Retinal fundus photograph, 2212 by 1659 pixels — 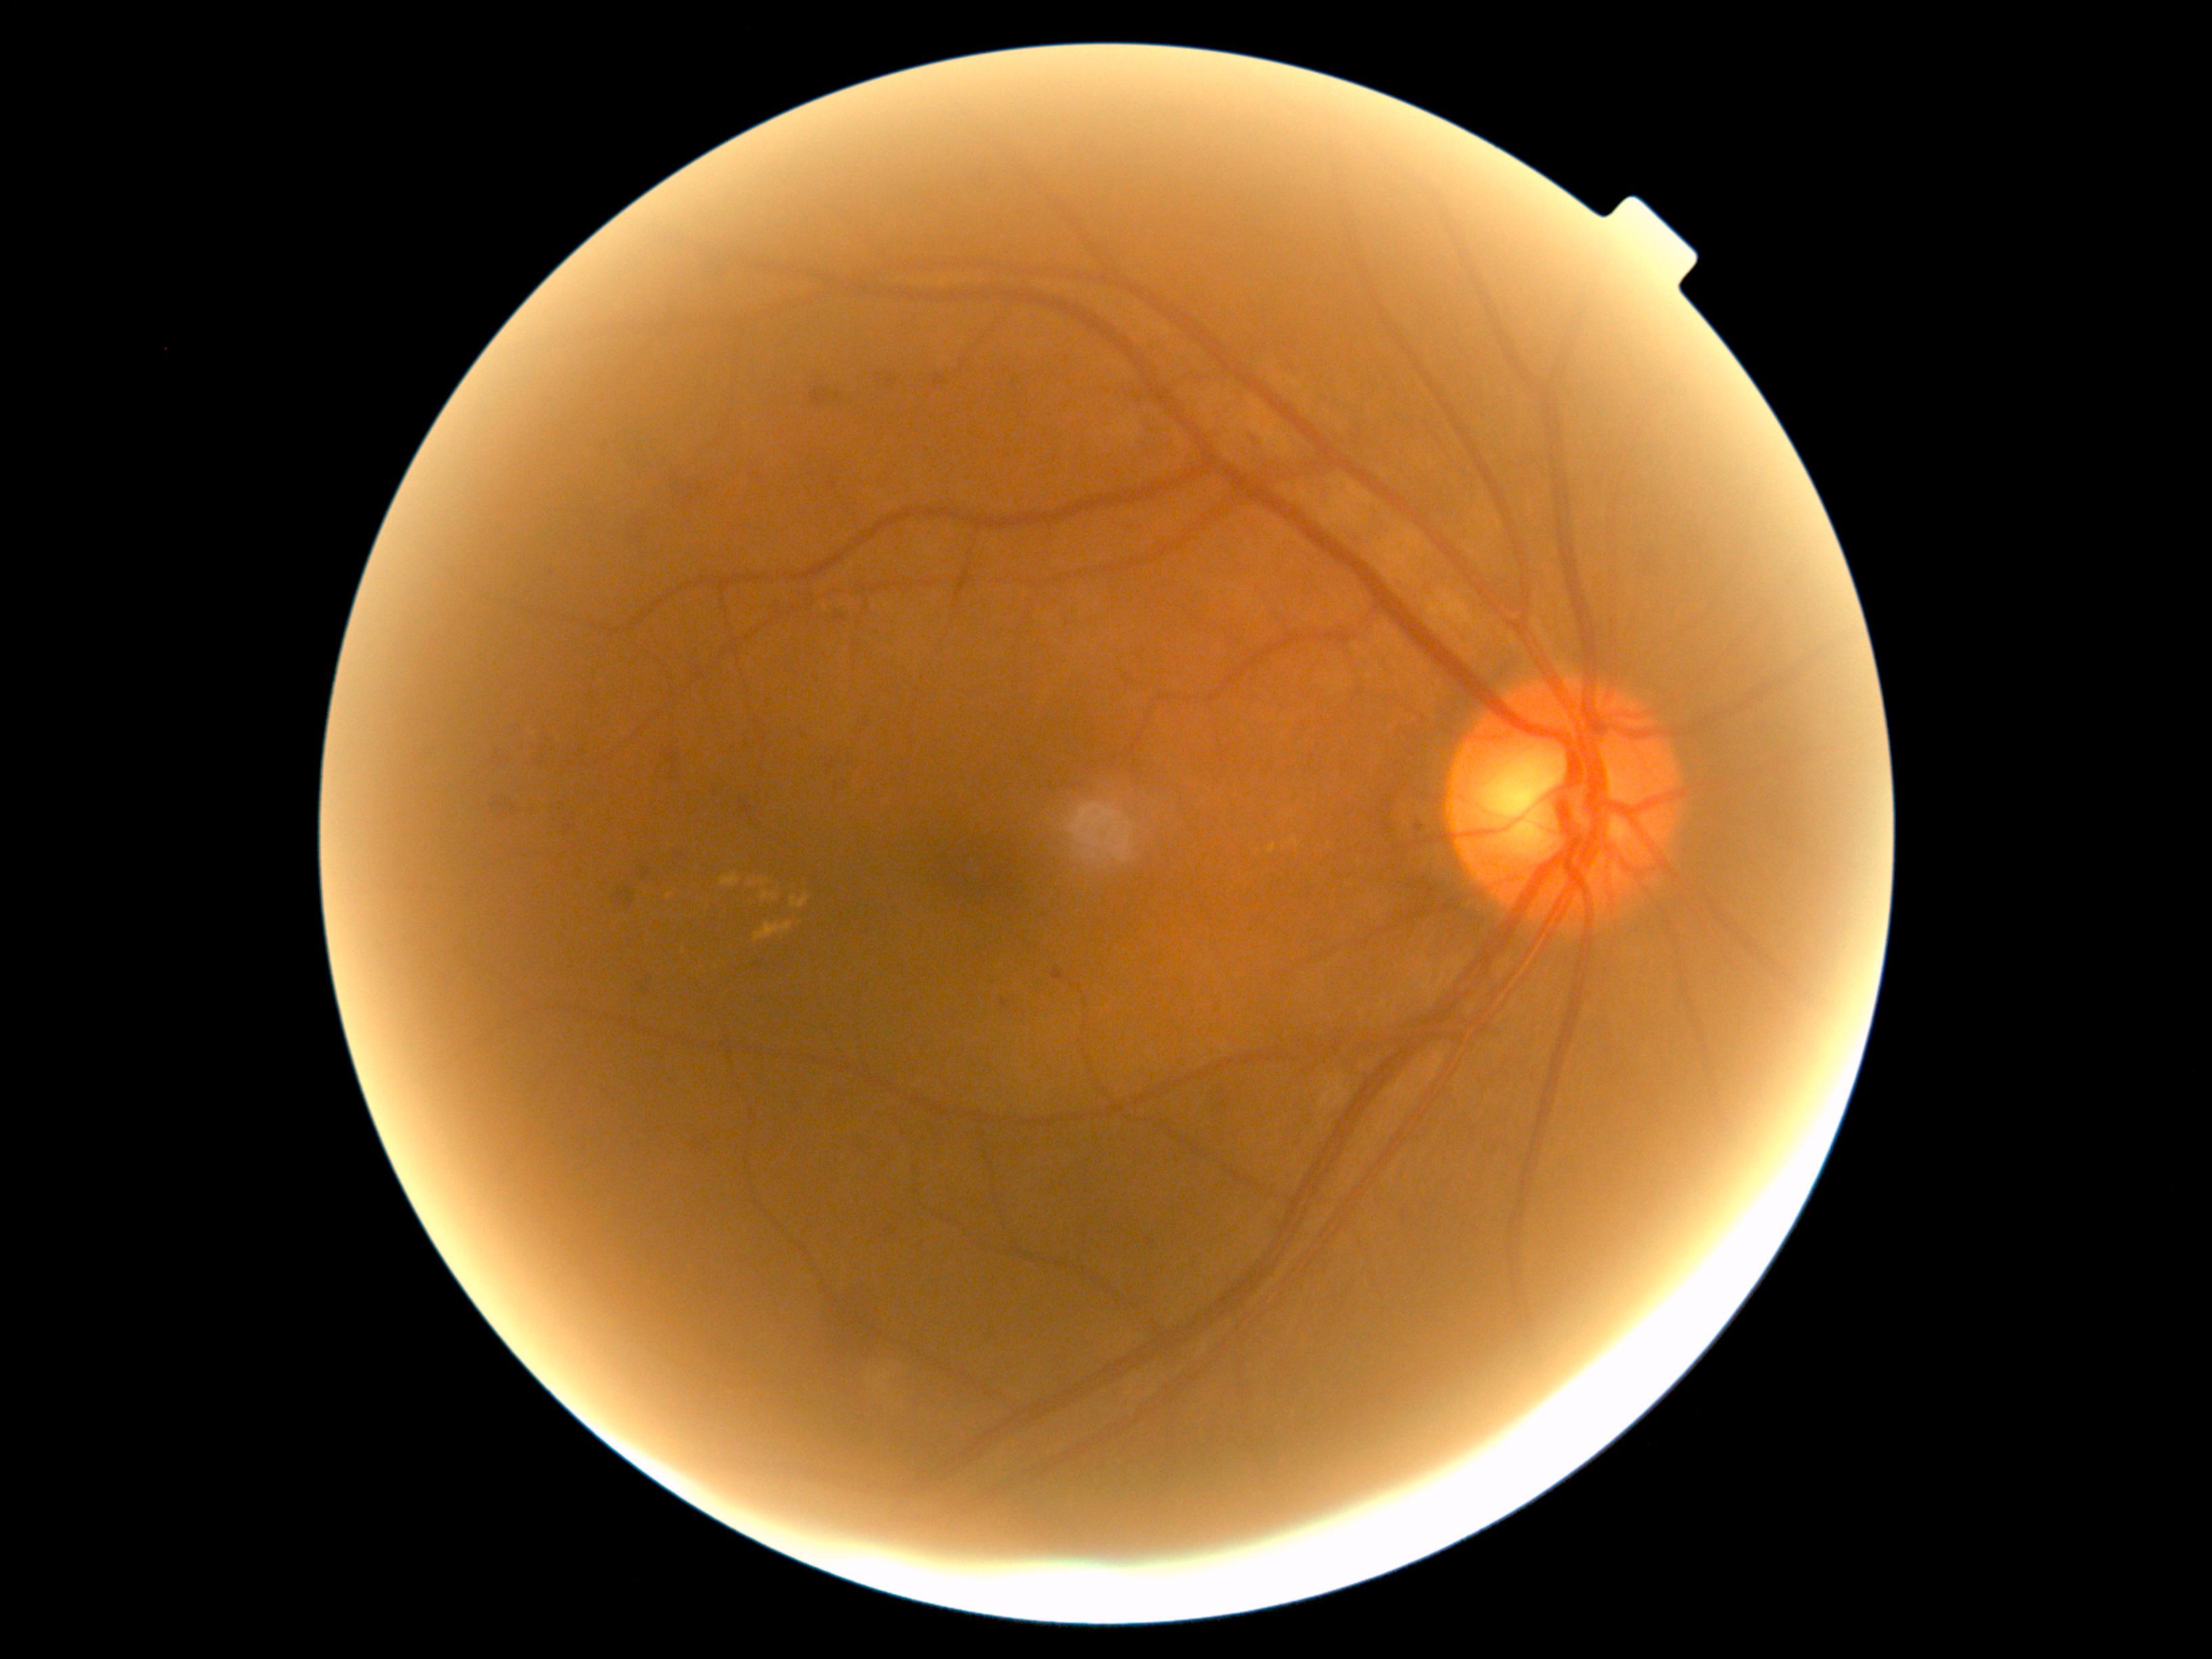

DR grade is 2 — more than just microaneurysms but less than severe NPDR. HEs include those at [x1=662, y1=747, x2=684, y2=780]; [x1=1001, y1=1000, x2=1009, y2=1008]; [x1=1242, y1=425, x2=1268, y2=445]; [x1=609, y1=880, x2=638, y2=913]; [x1=1119, y1=516, x2=1149, y2=536]; [x1=1145, y1=1237, x2=1155, y2=1246]; [x1=555, y1=814, x2=583, y2=838]; [x1=806, y1=375, x2=845, y2=411]; [x1=692, y1=1134, x2=715, y2=1158]; [x1=630, y1=714, x2=640, y2=723]; [x1=874, y1=364, x2=906, y2=396]; [x1=486, y1=792, x2=518, y2=822]; [x1=1409, y1=817, x2=1424, y2=833]; [x1=1313, y1=487, x2=1333, y2=504]; [x1=670, y1=470, x2=712, y2=516]; [x1=1052, y1=970, x2=1066, y2=982]; [x1=830, y1=604, x2=855, y2=624]. Additional small HEs near 1045:915.